1971x1876 — 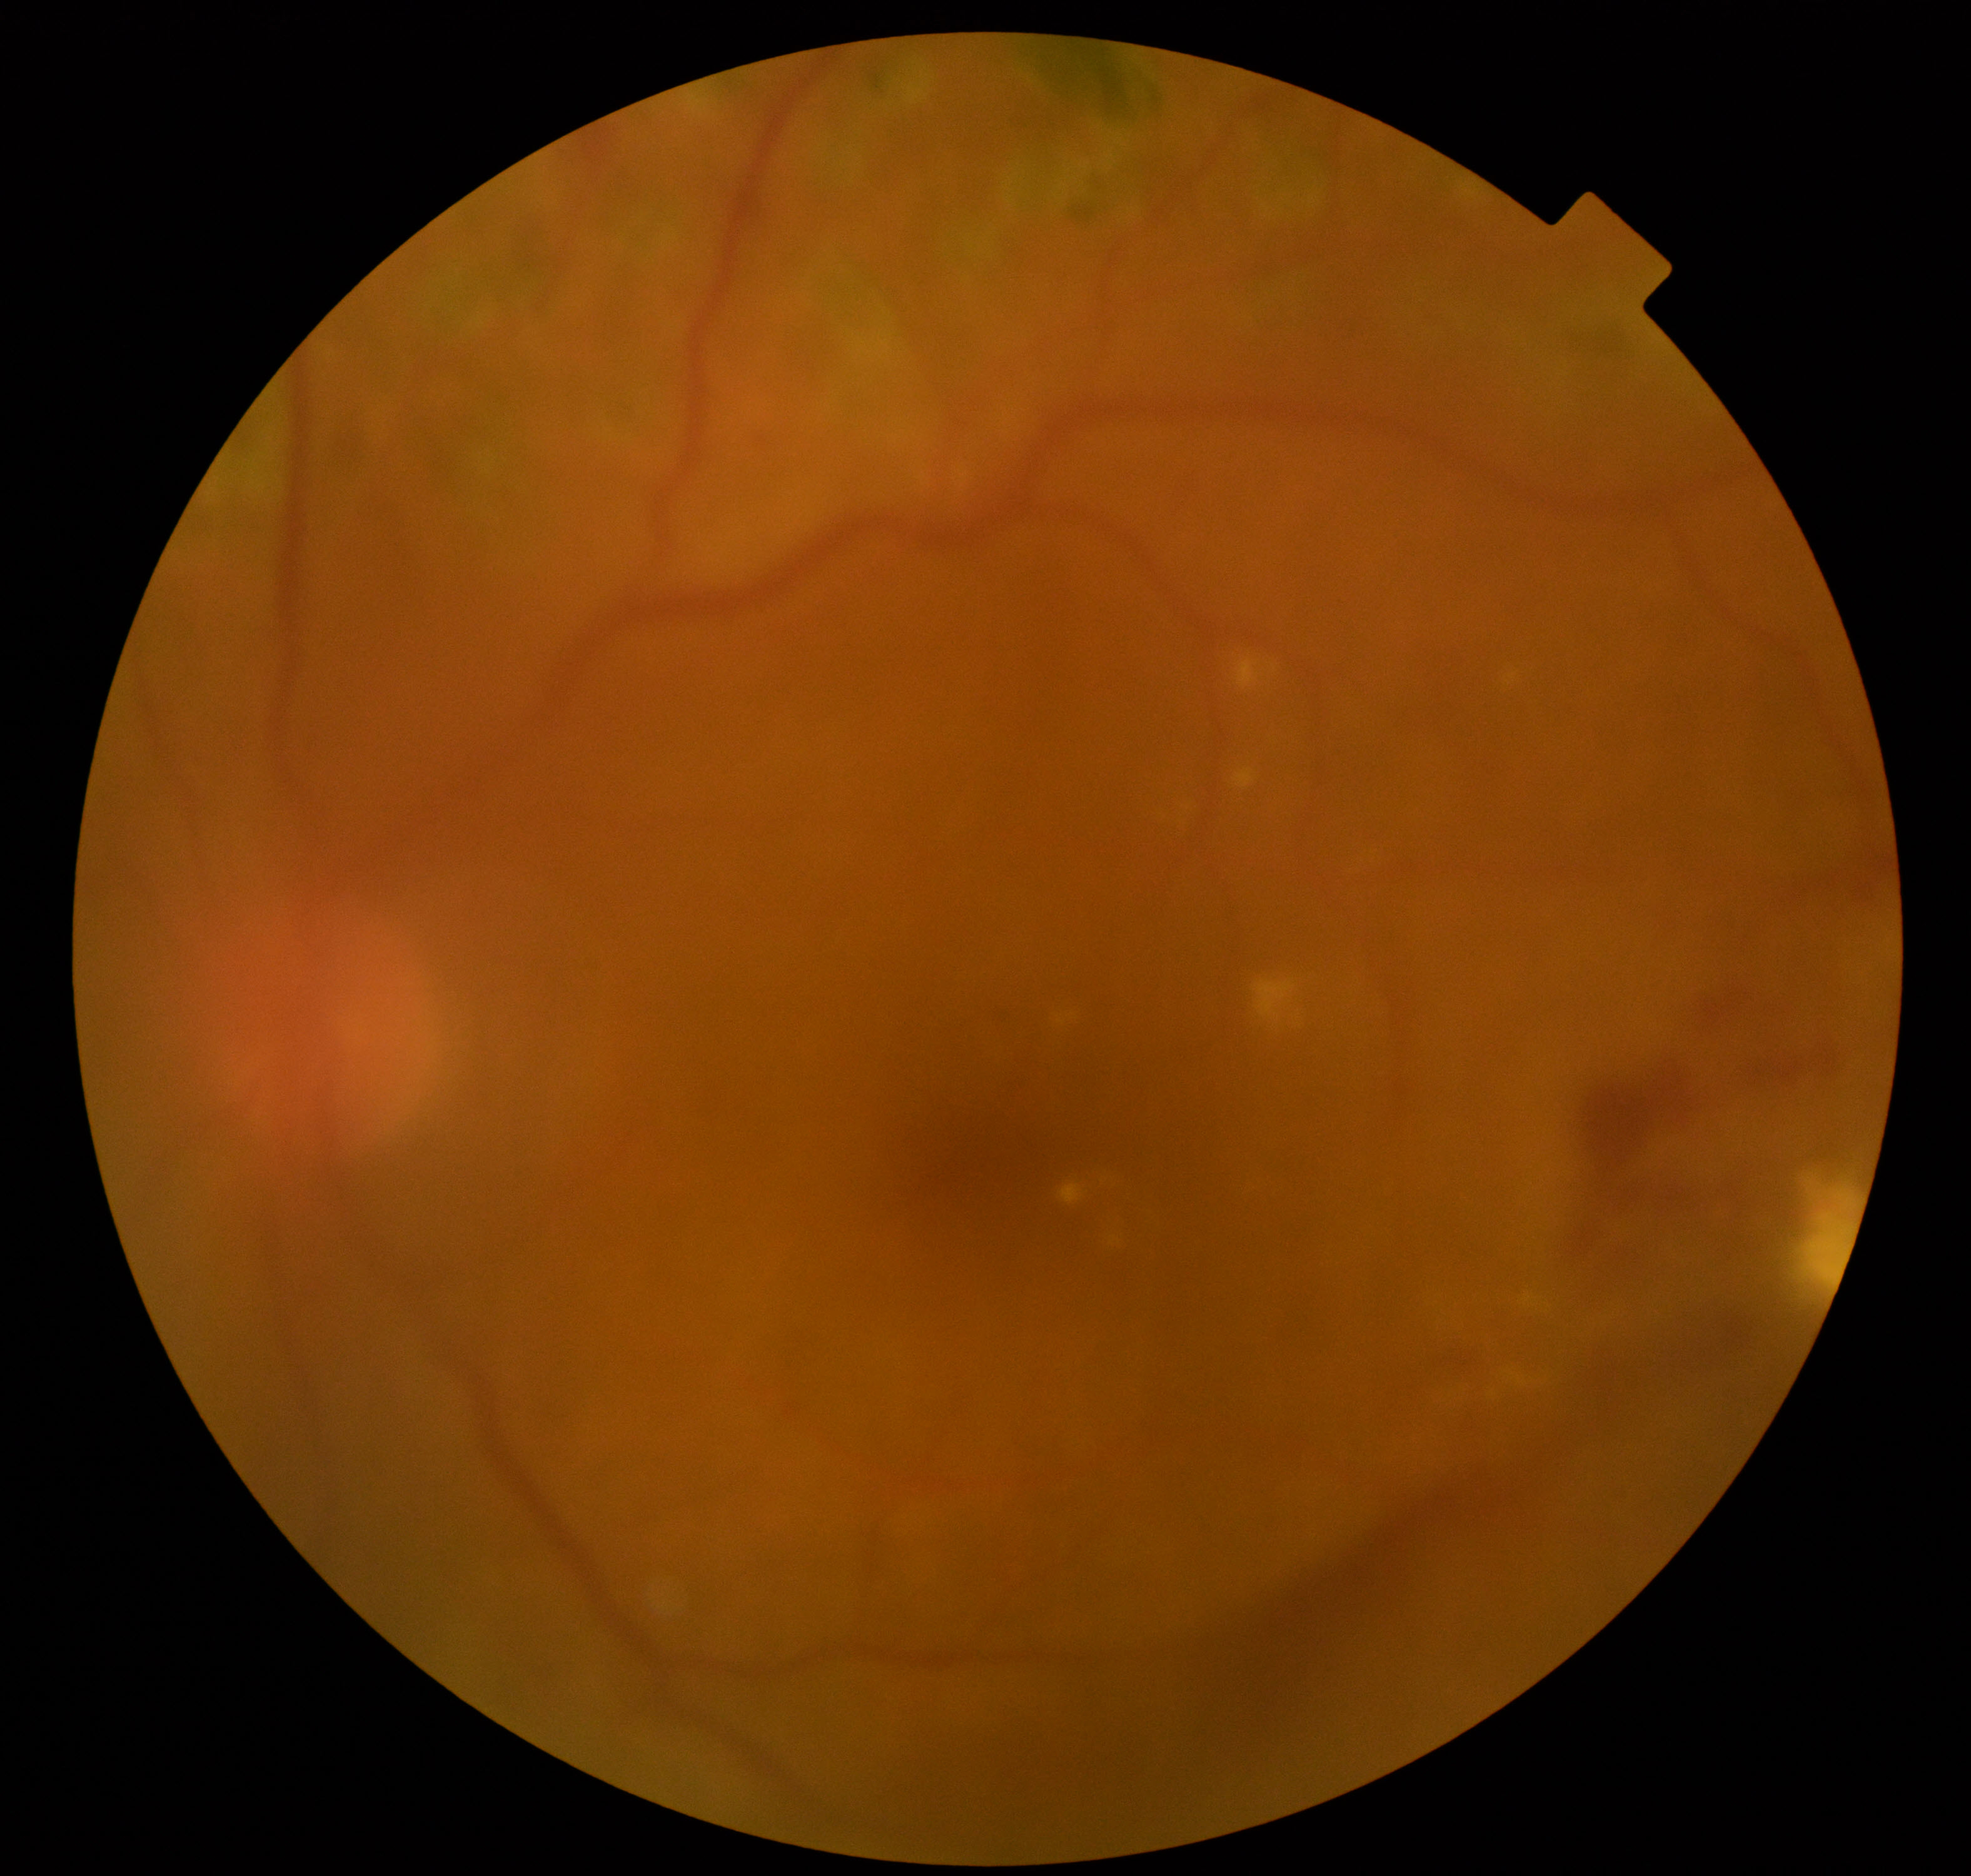
Image is blurred; retinal landmarks are largely obscured. Features suspicious for proliferative diabetic retinopathy.